Modified Davis grading — 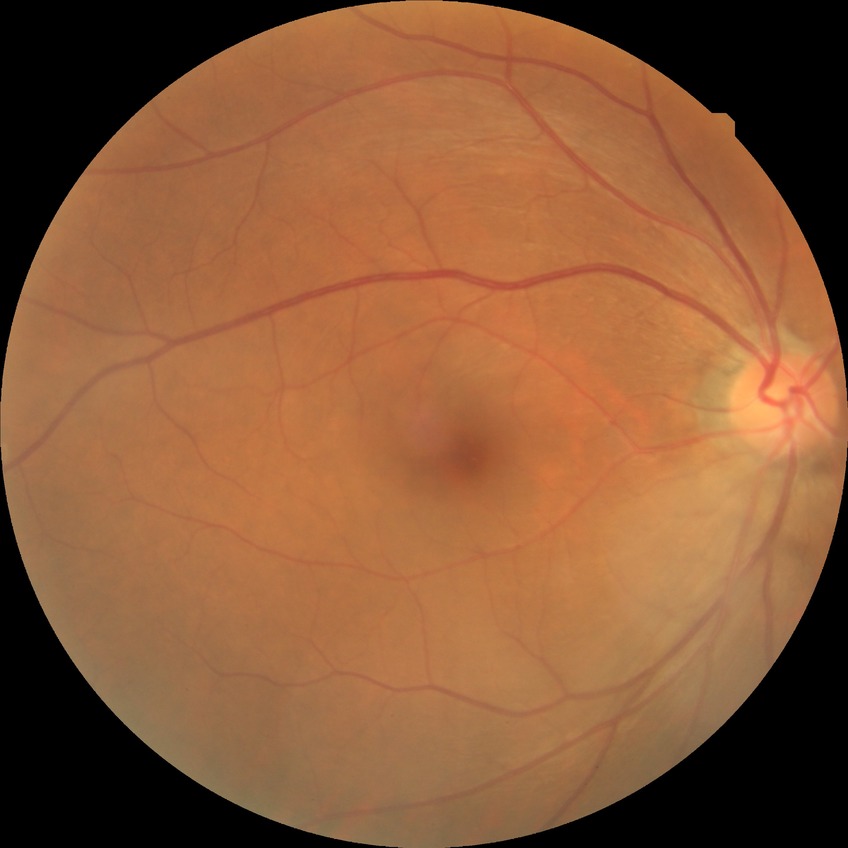
  davis_grade: NDR